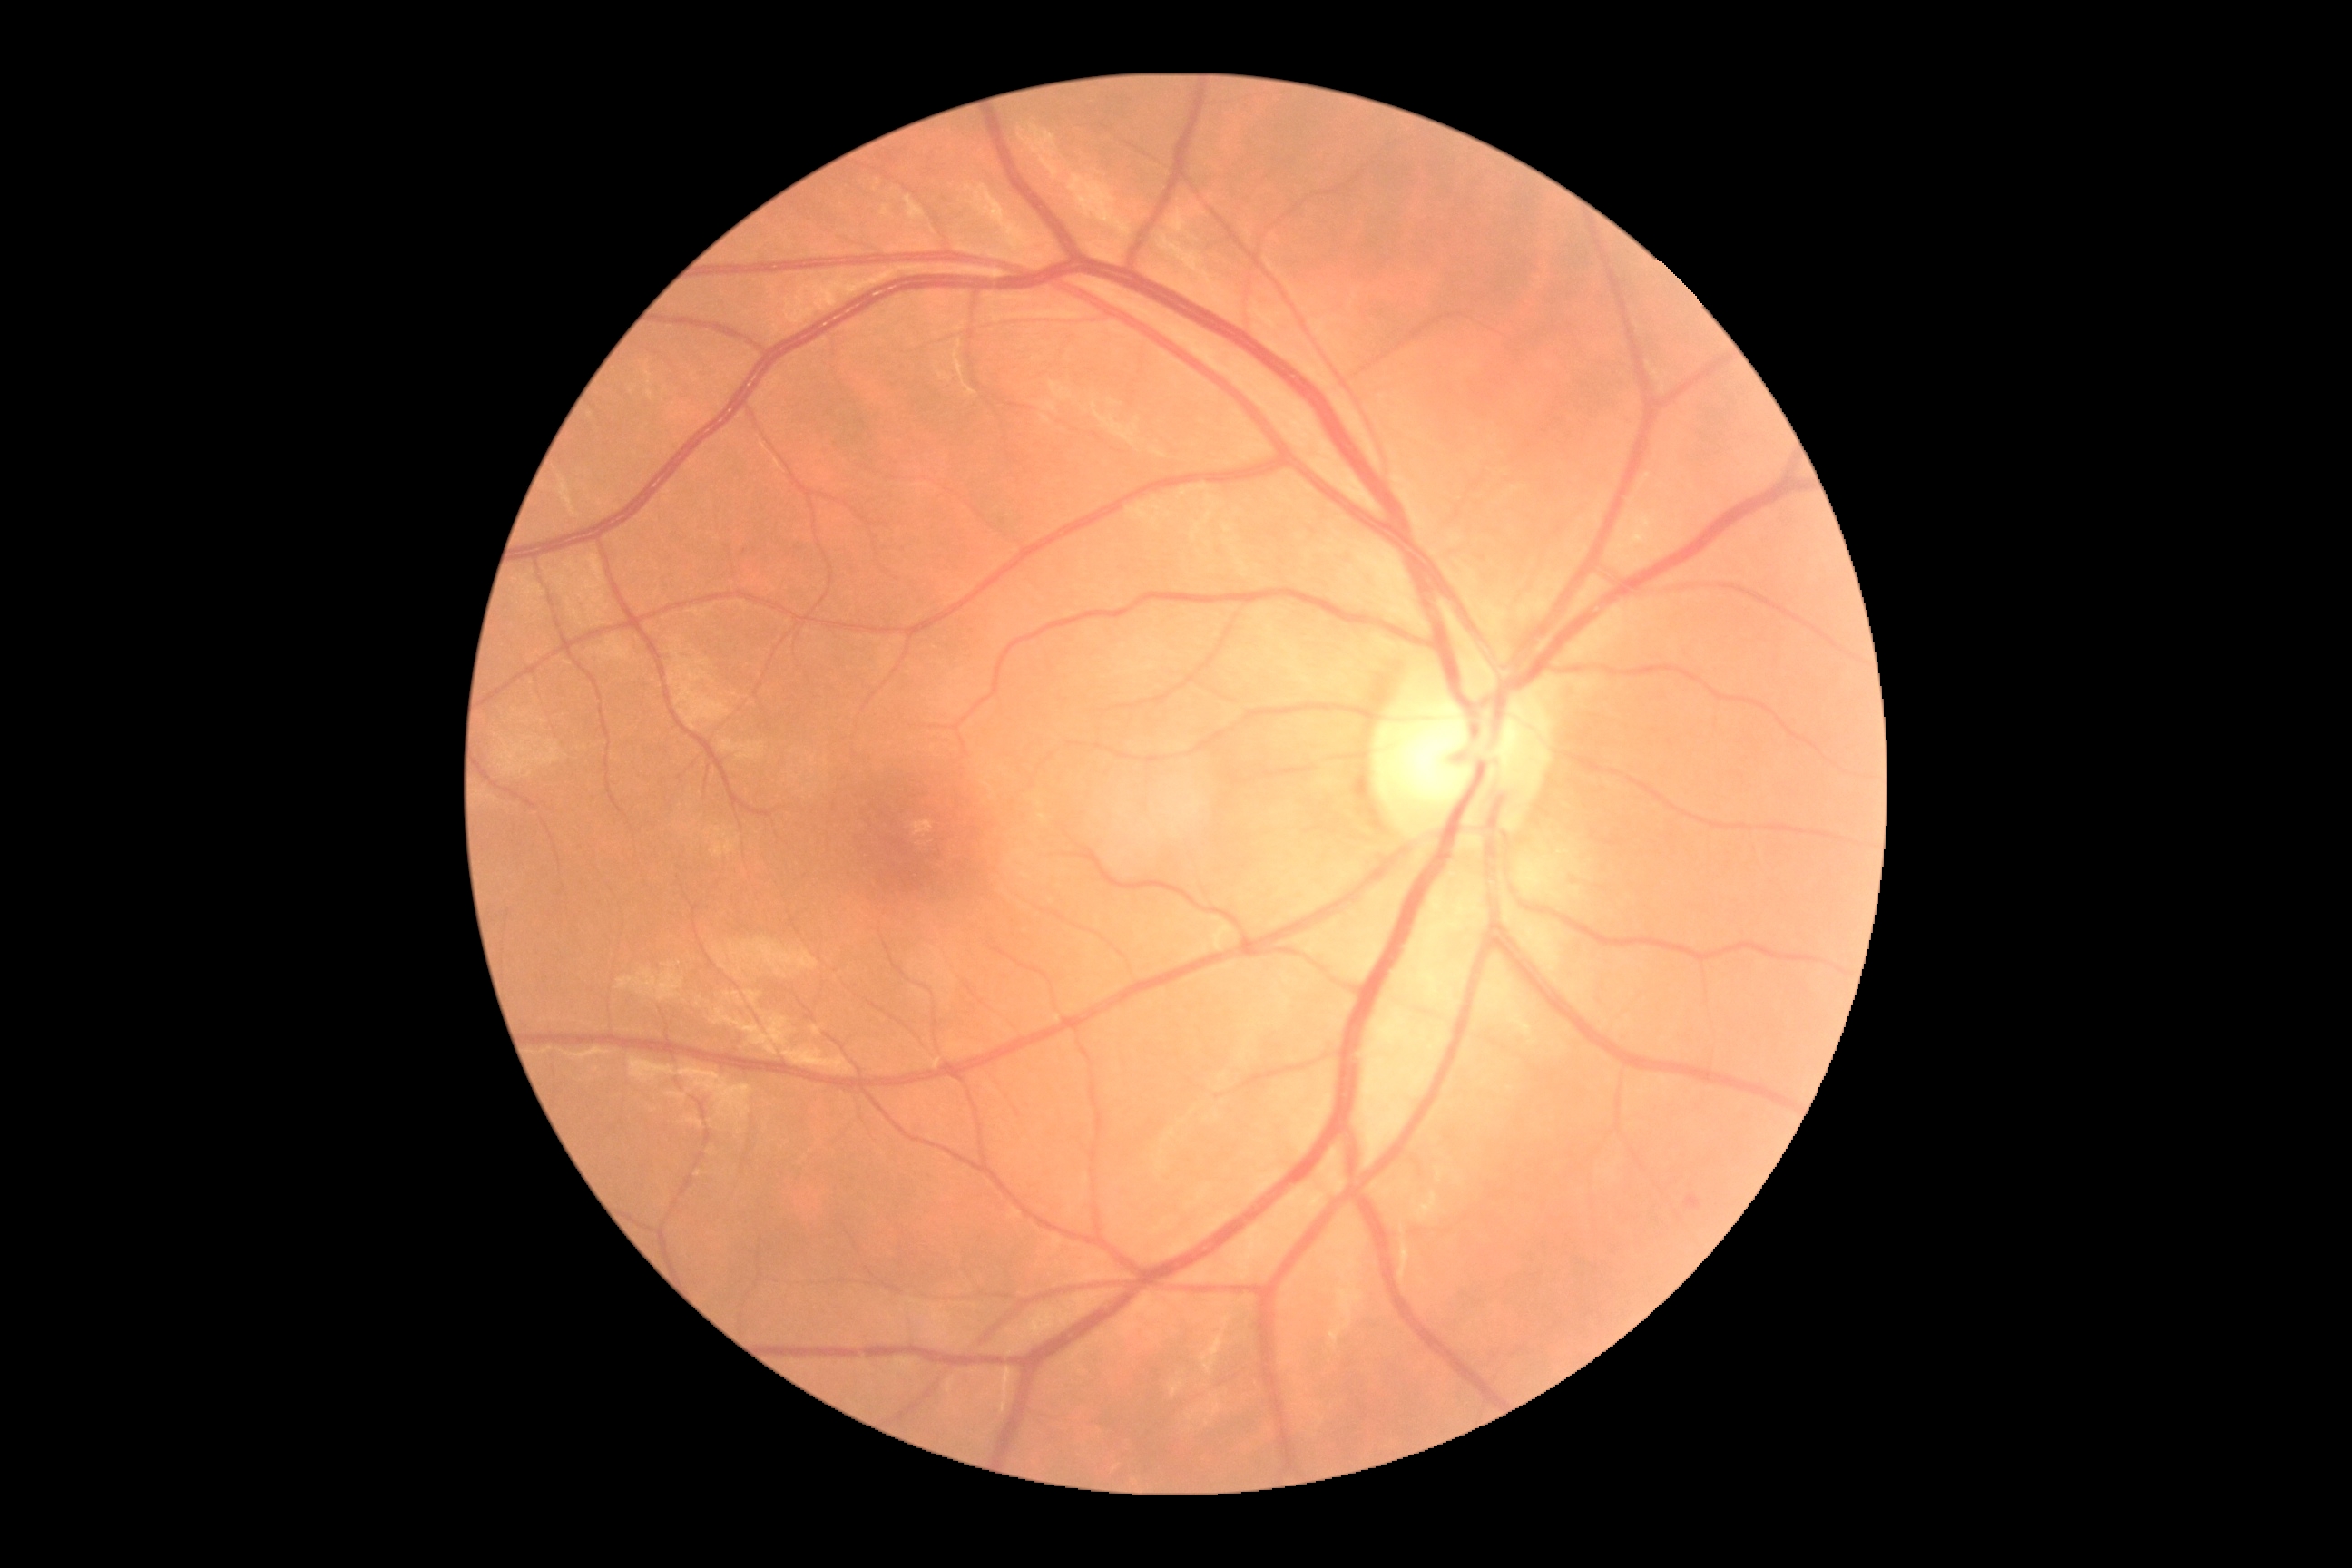
DR class: non-proliferative diabetic retinopathy; DR: 2/4.